1624 x 1232 pixels; fundus photo
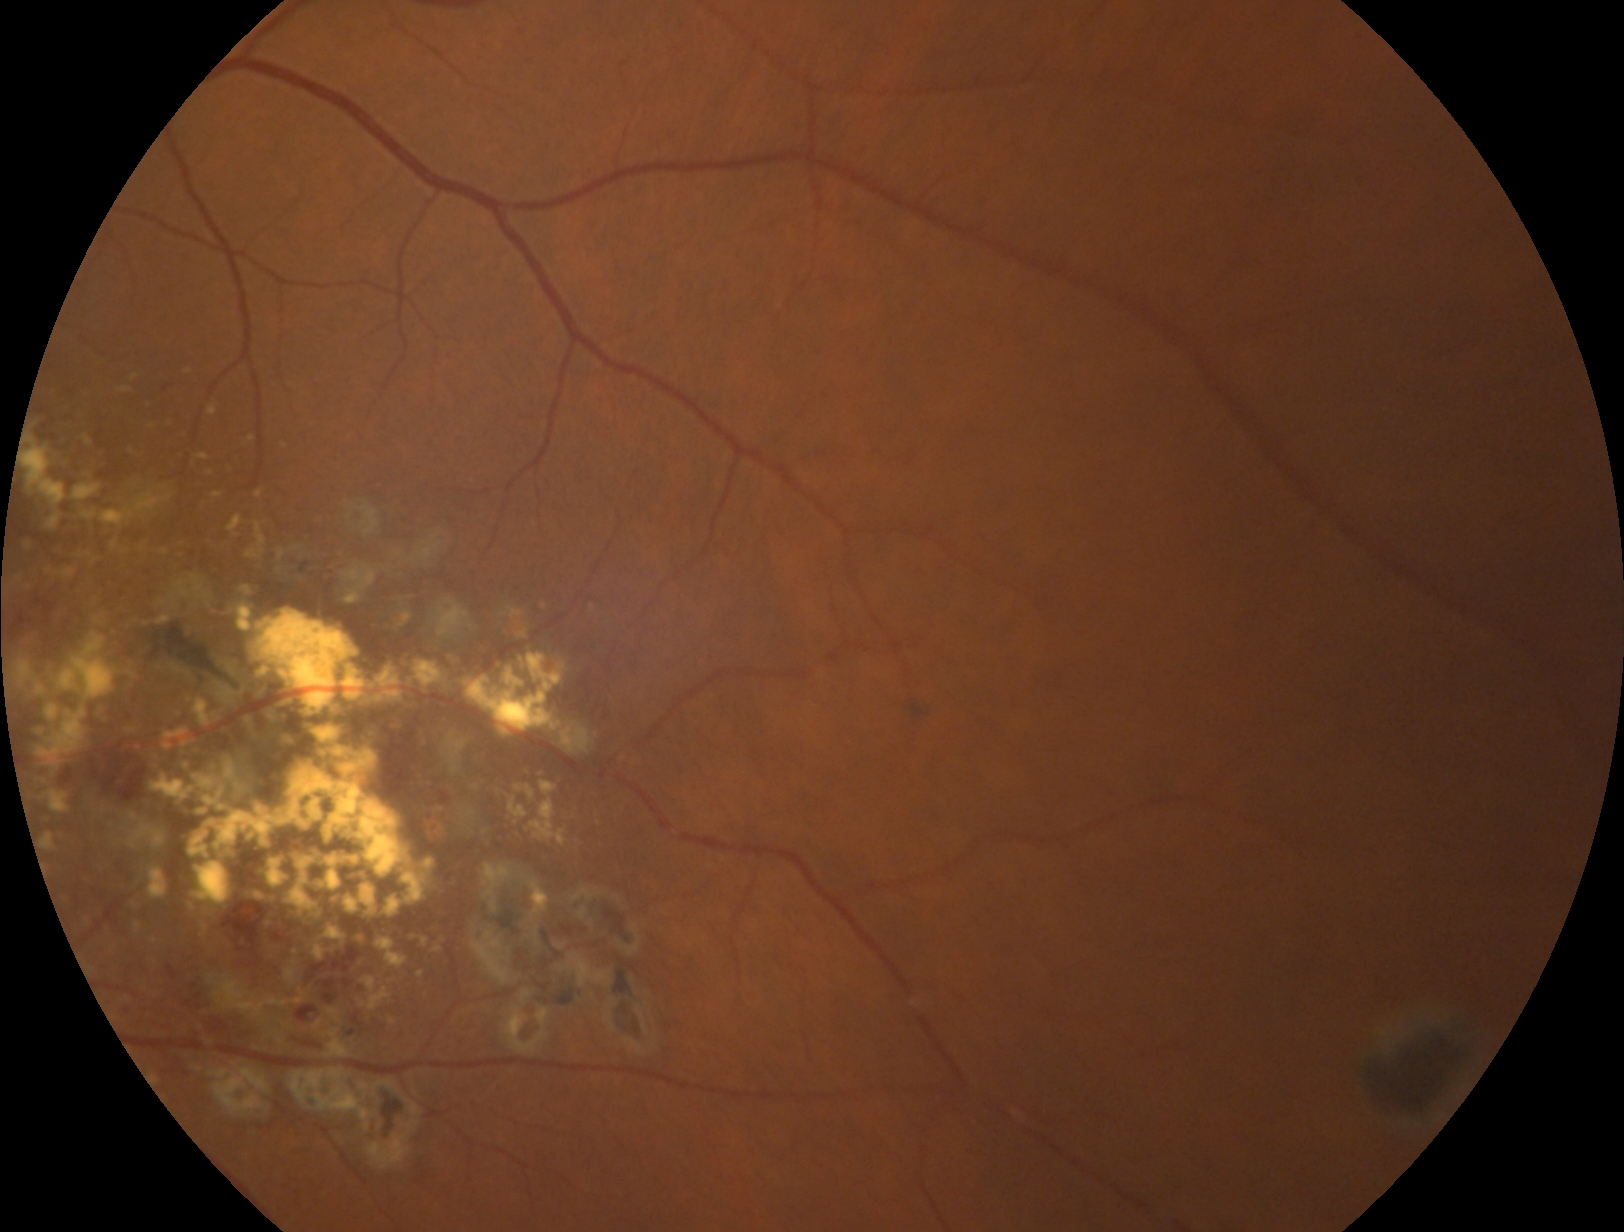

Diabetic retinopathy (DR) is 2.